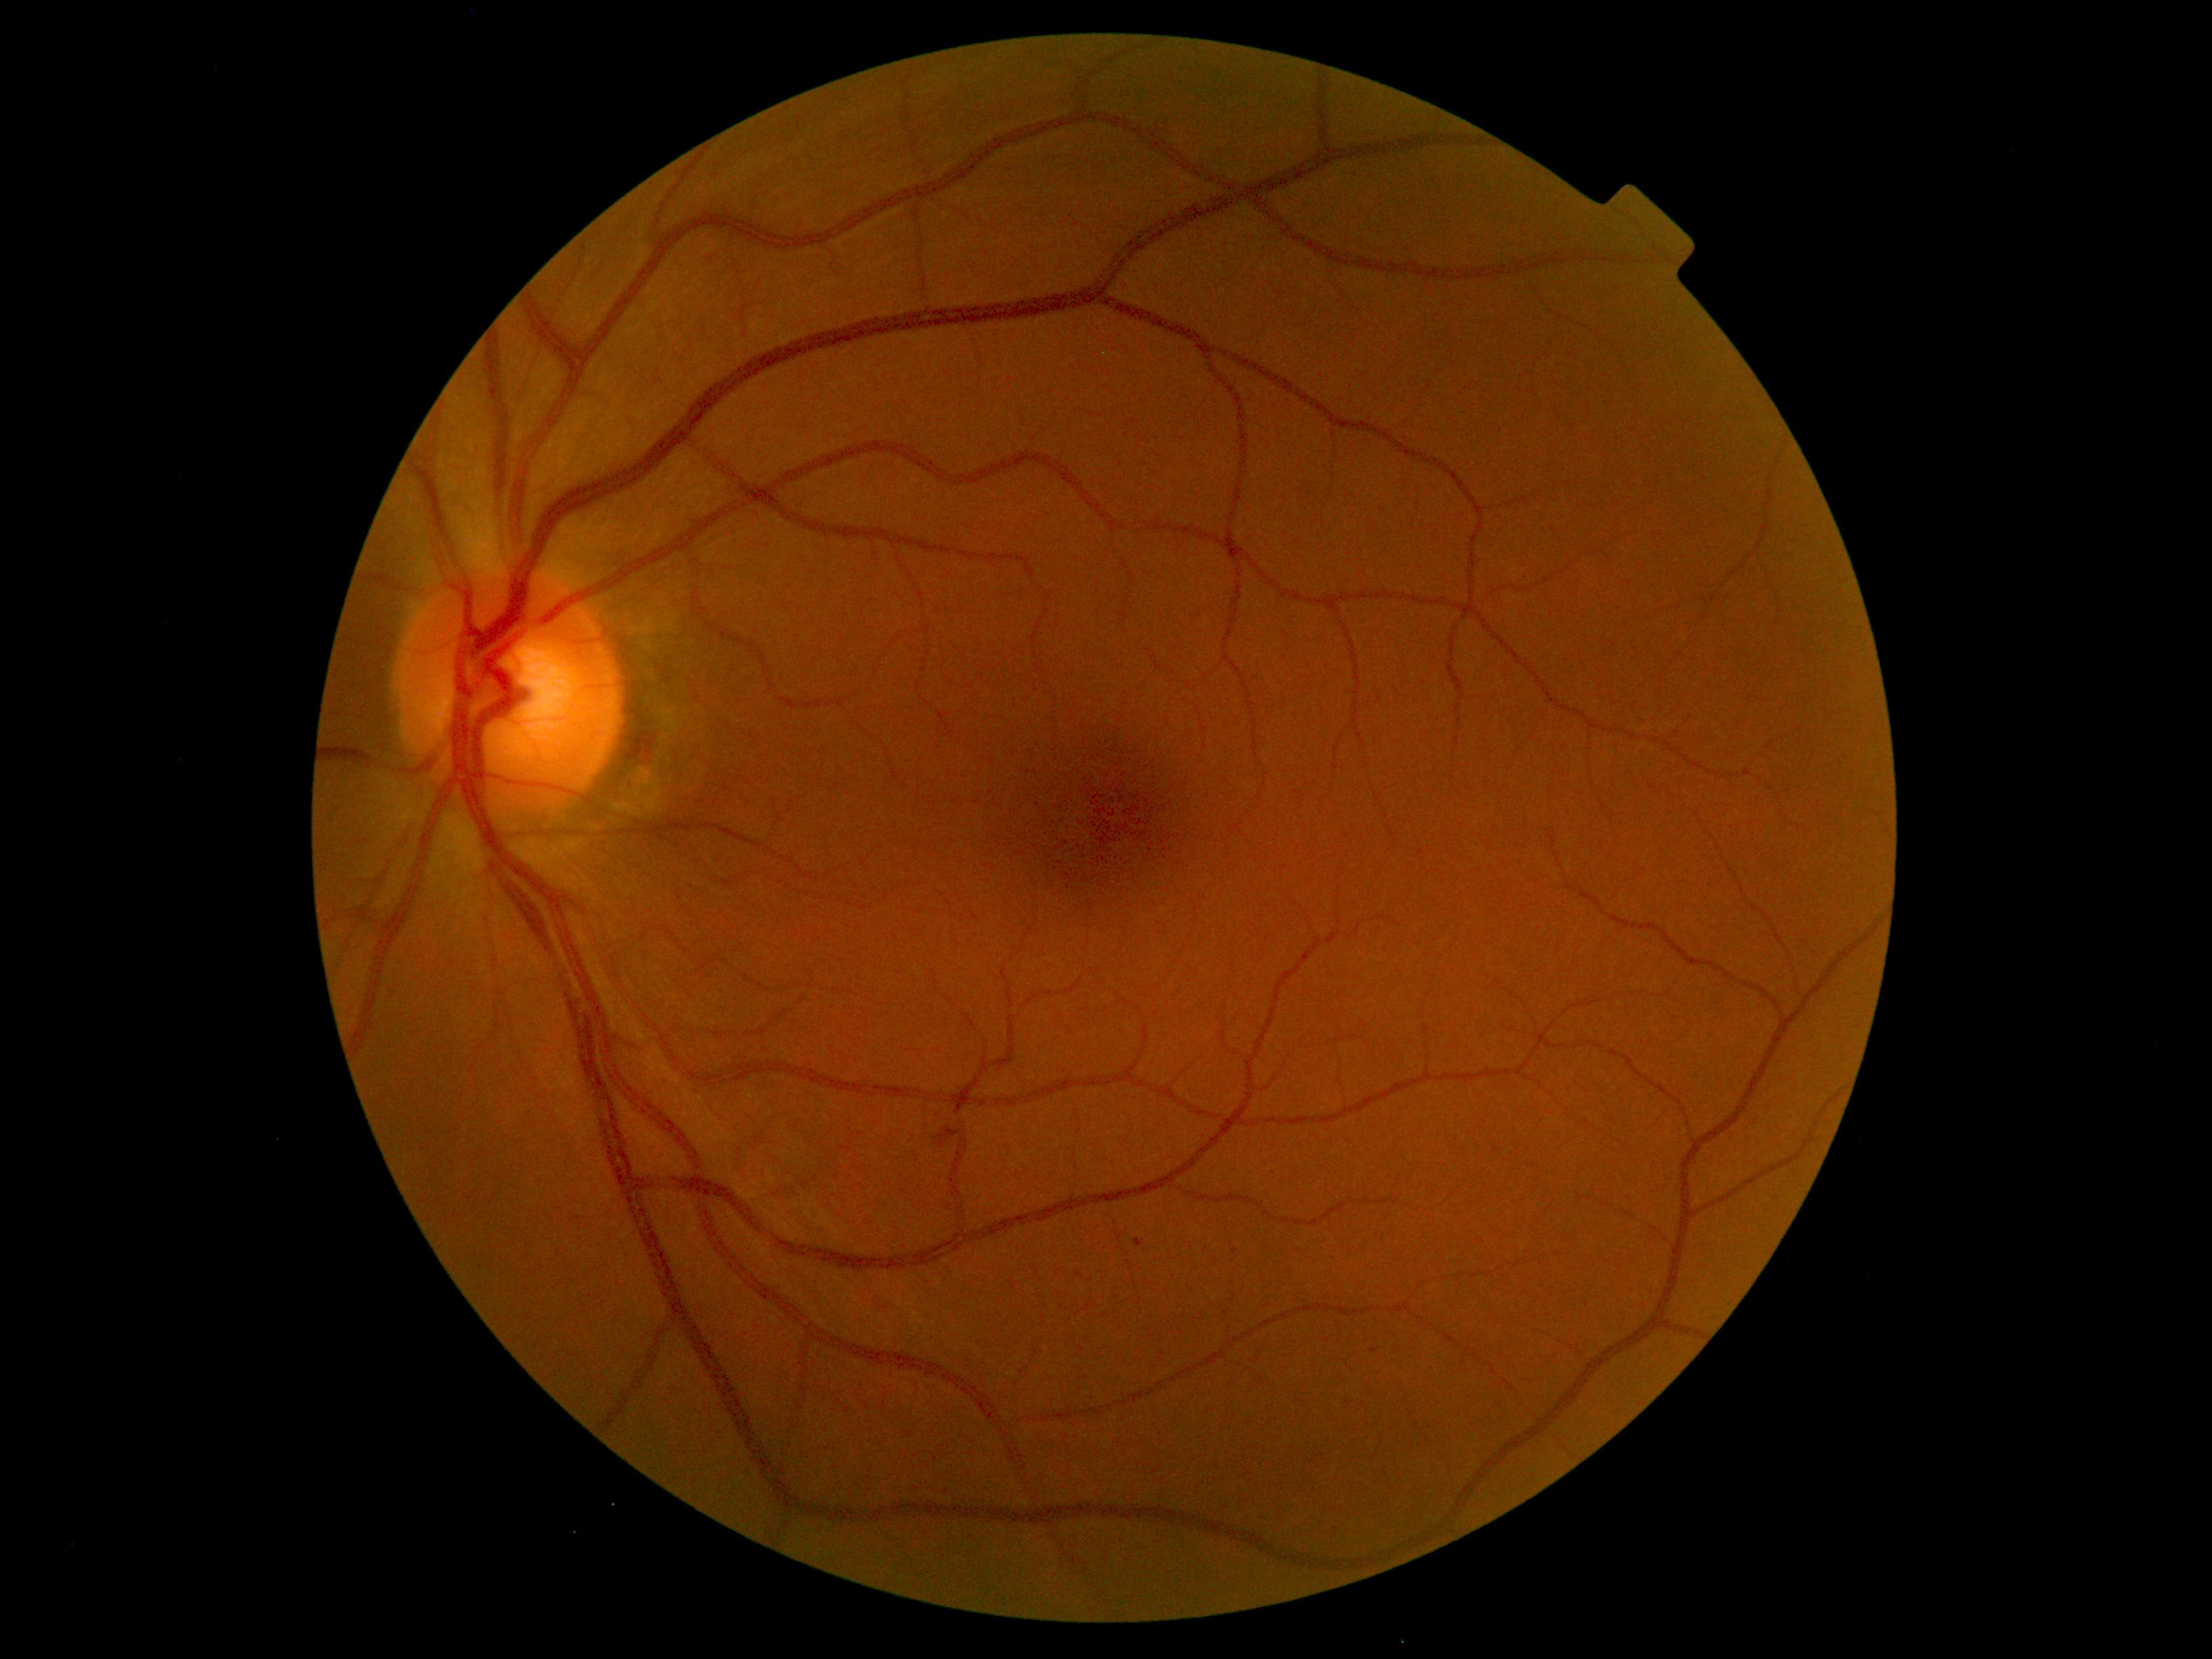 Diabetic retinopathy (DR): grade 1 (mild NPDR)
Findings:
• hard exudates (EXs): none detected
• hemorrhages (HEs): none detected
• soft exudates (SEs): none detected
• microaneurysms (MAs): rect(1135, 1238, 1143, 1248) | rect(939, 1127, 963, 1149)